Dilated pupil. FOV 35° before cropping. Optic nerve head photograph
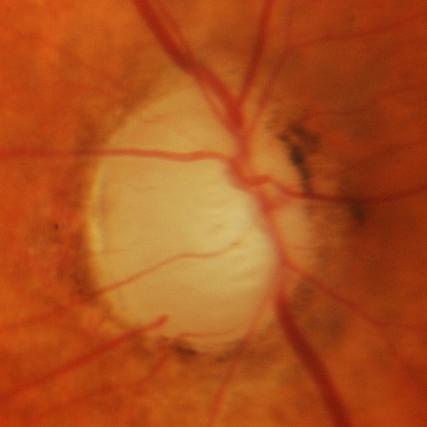 Glaucoma is present. Finding = glaucomatous changes.